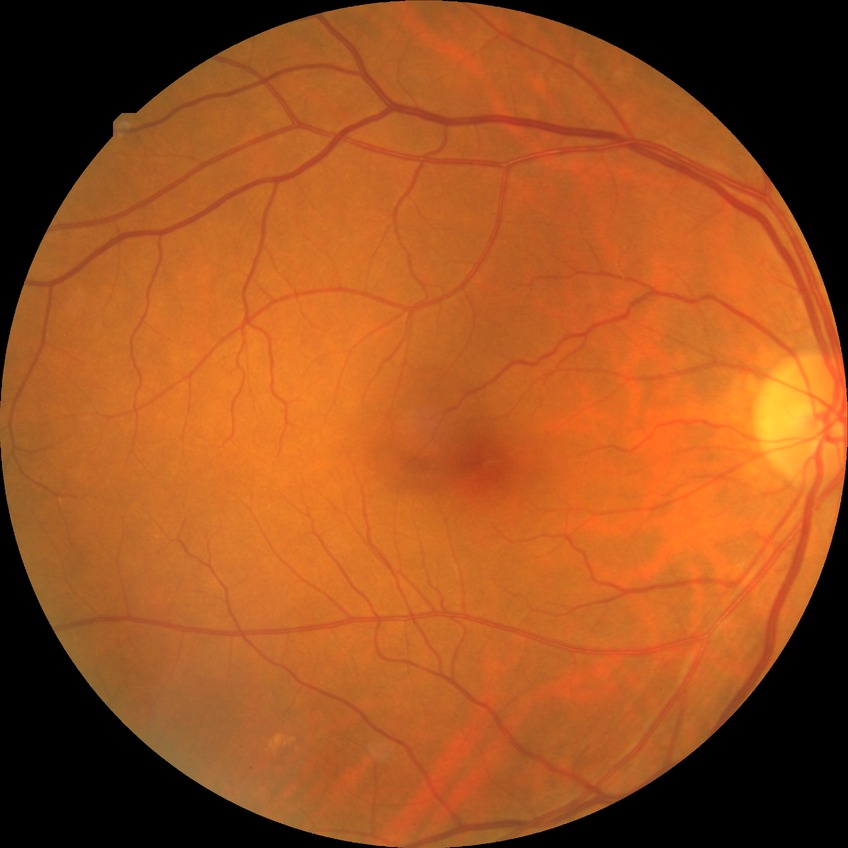

{"davis_grade": "no diabetic retinopathy (NDR)"}